Wide-field fundus photograph of an infant — 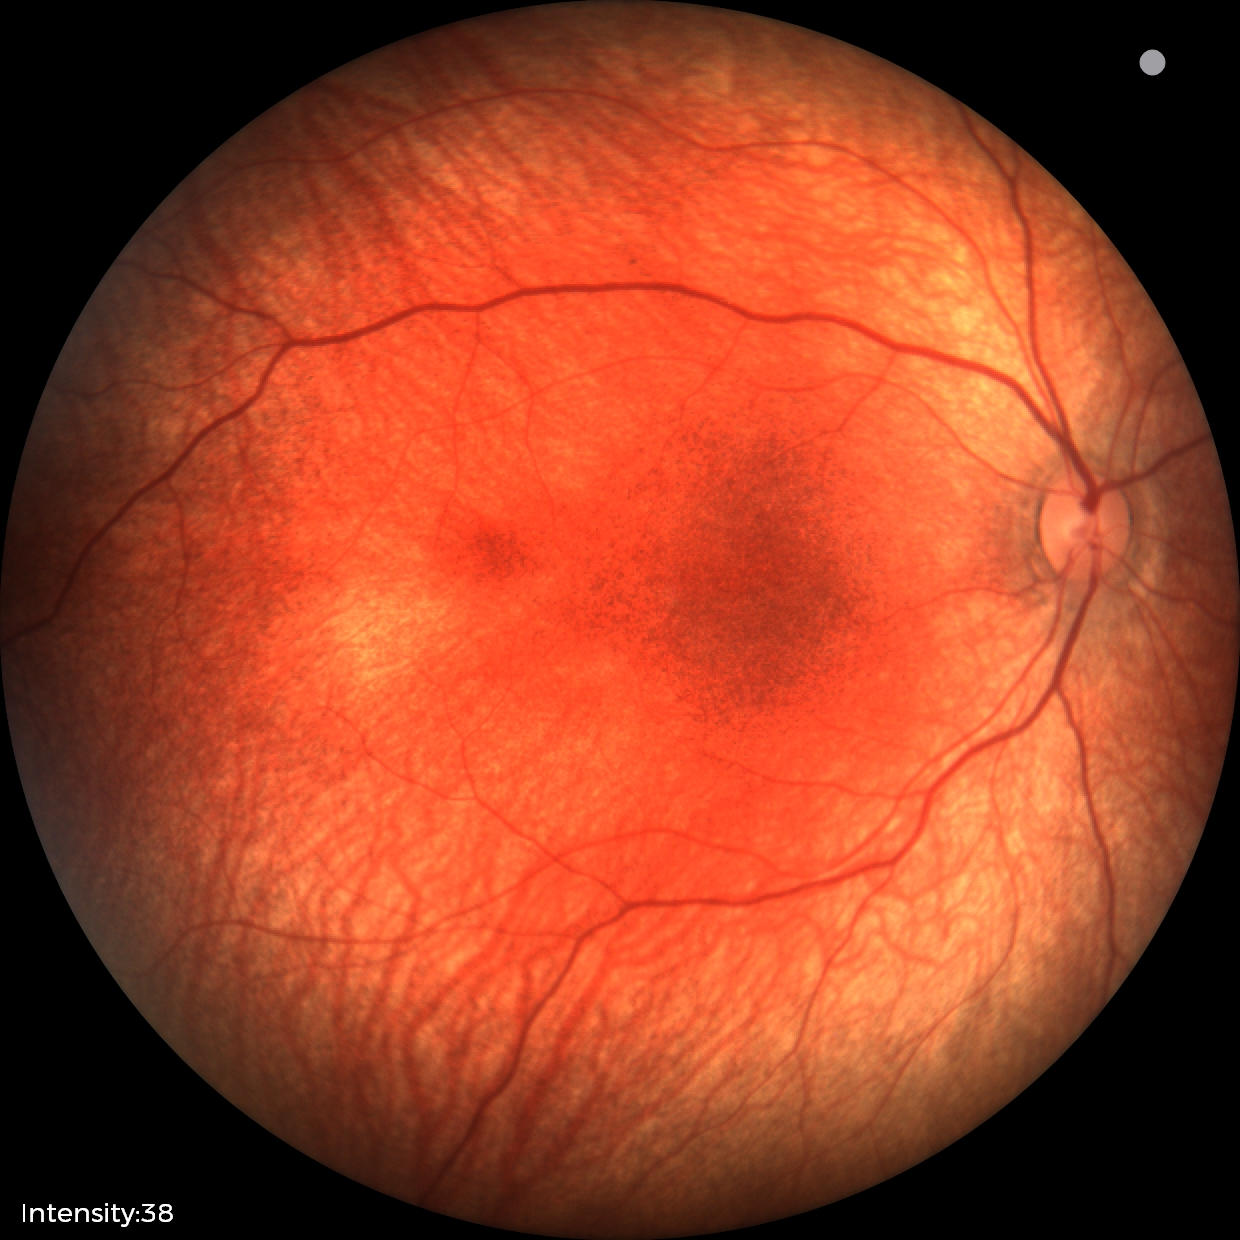
Screening examination consistent with retinal hemorrhages.